Wide-field fundus photograph from neonatal ROP screening; Phoenix ICON, 100° FOV: 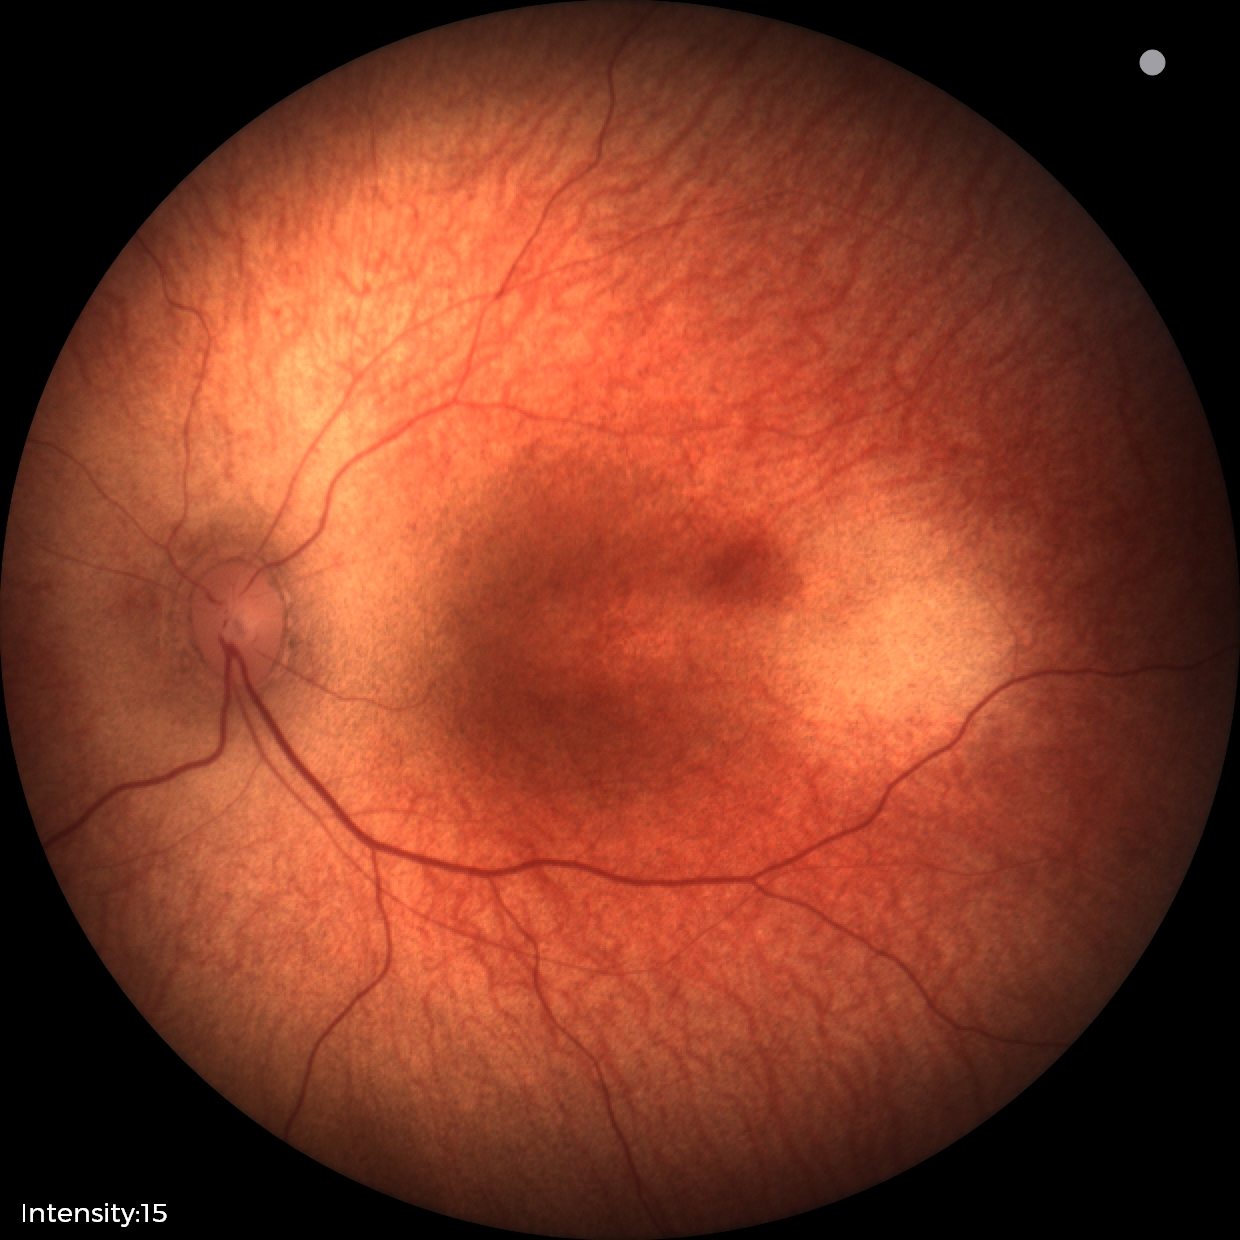 Physiological retinal appearance for postconceptual age.